Infant wide-field retinal image: 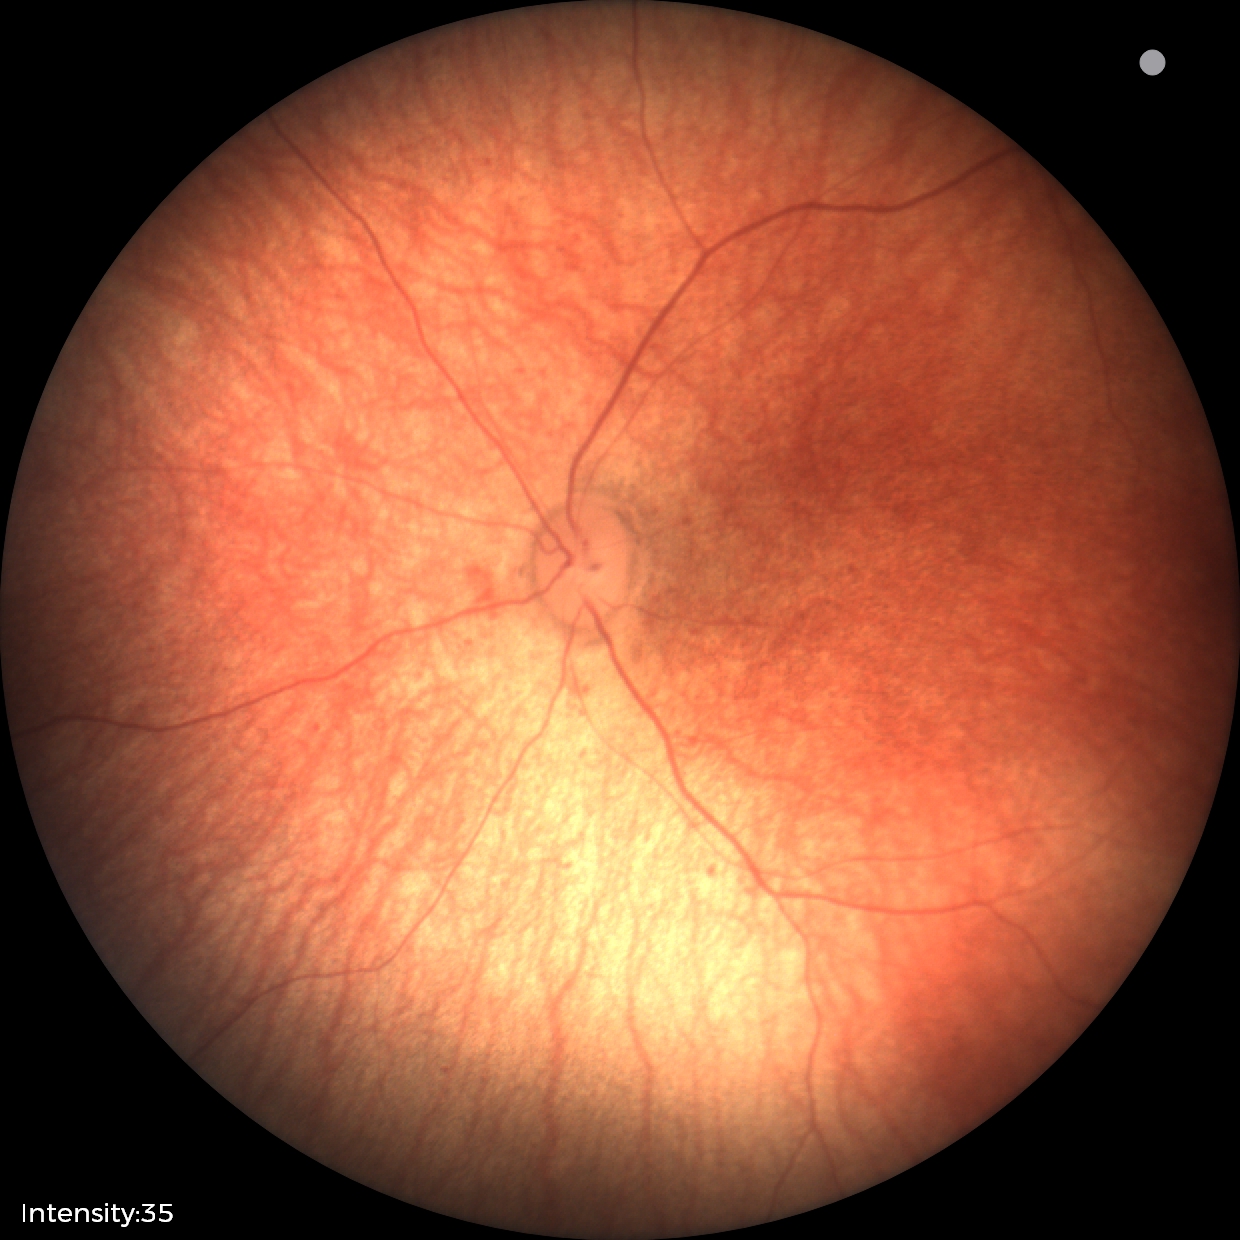
Diagnosis: normal retinal appearance.